Acquired with a NIDEK AFC-230. 45 degree fundus photograph — 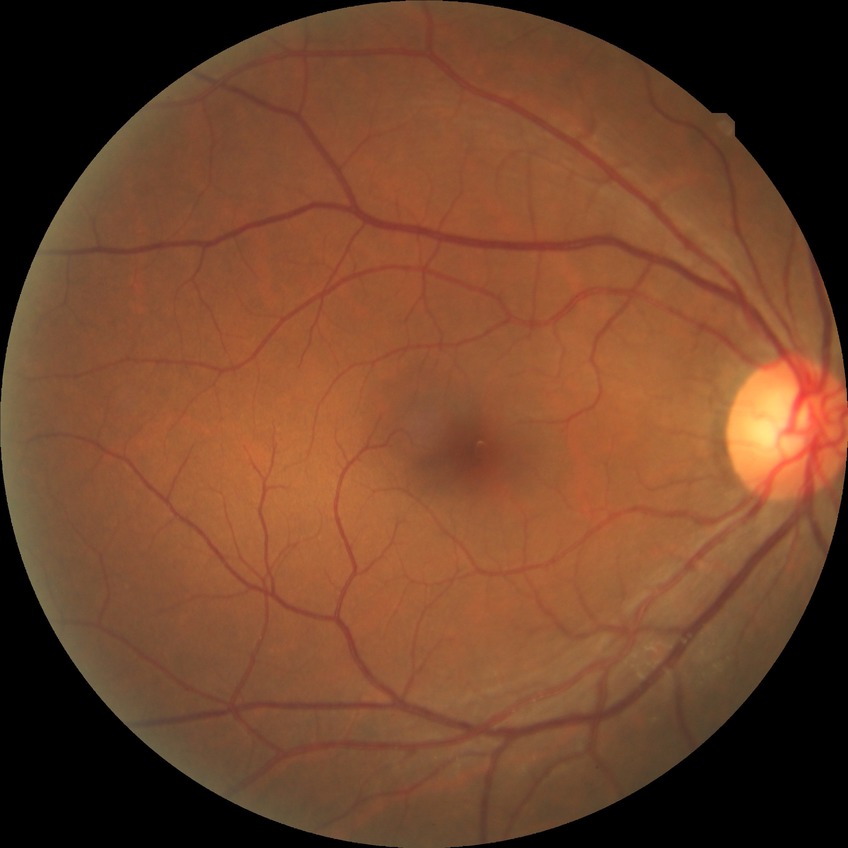 Retinopathy grade: no diabetic retinopathy.